2352 x 1568 pixels, FOV: 45 degrees — 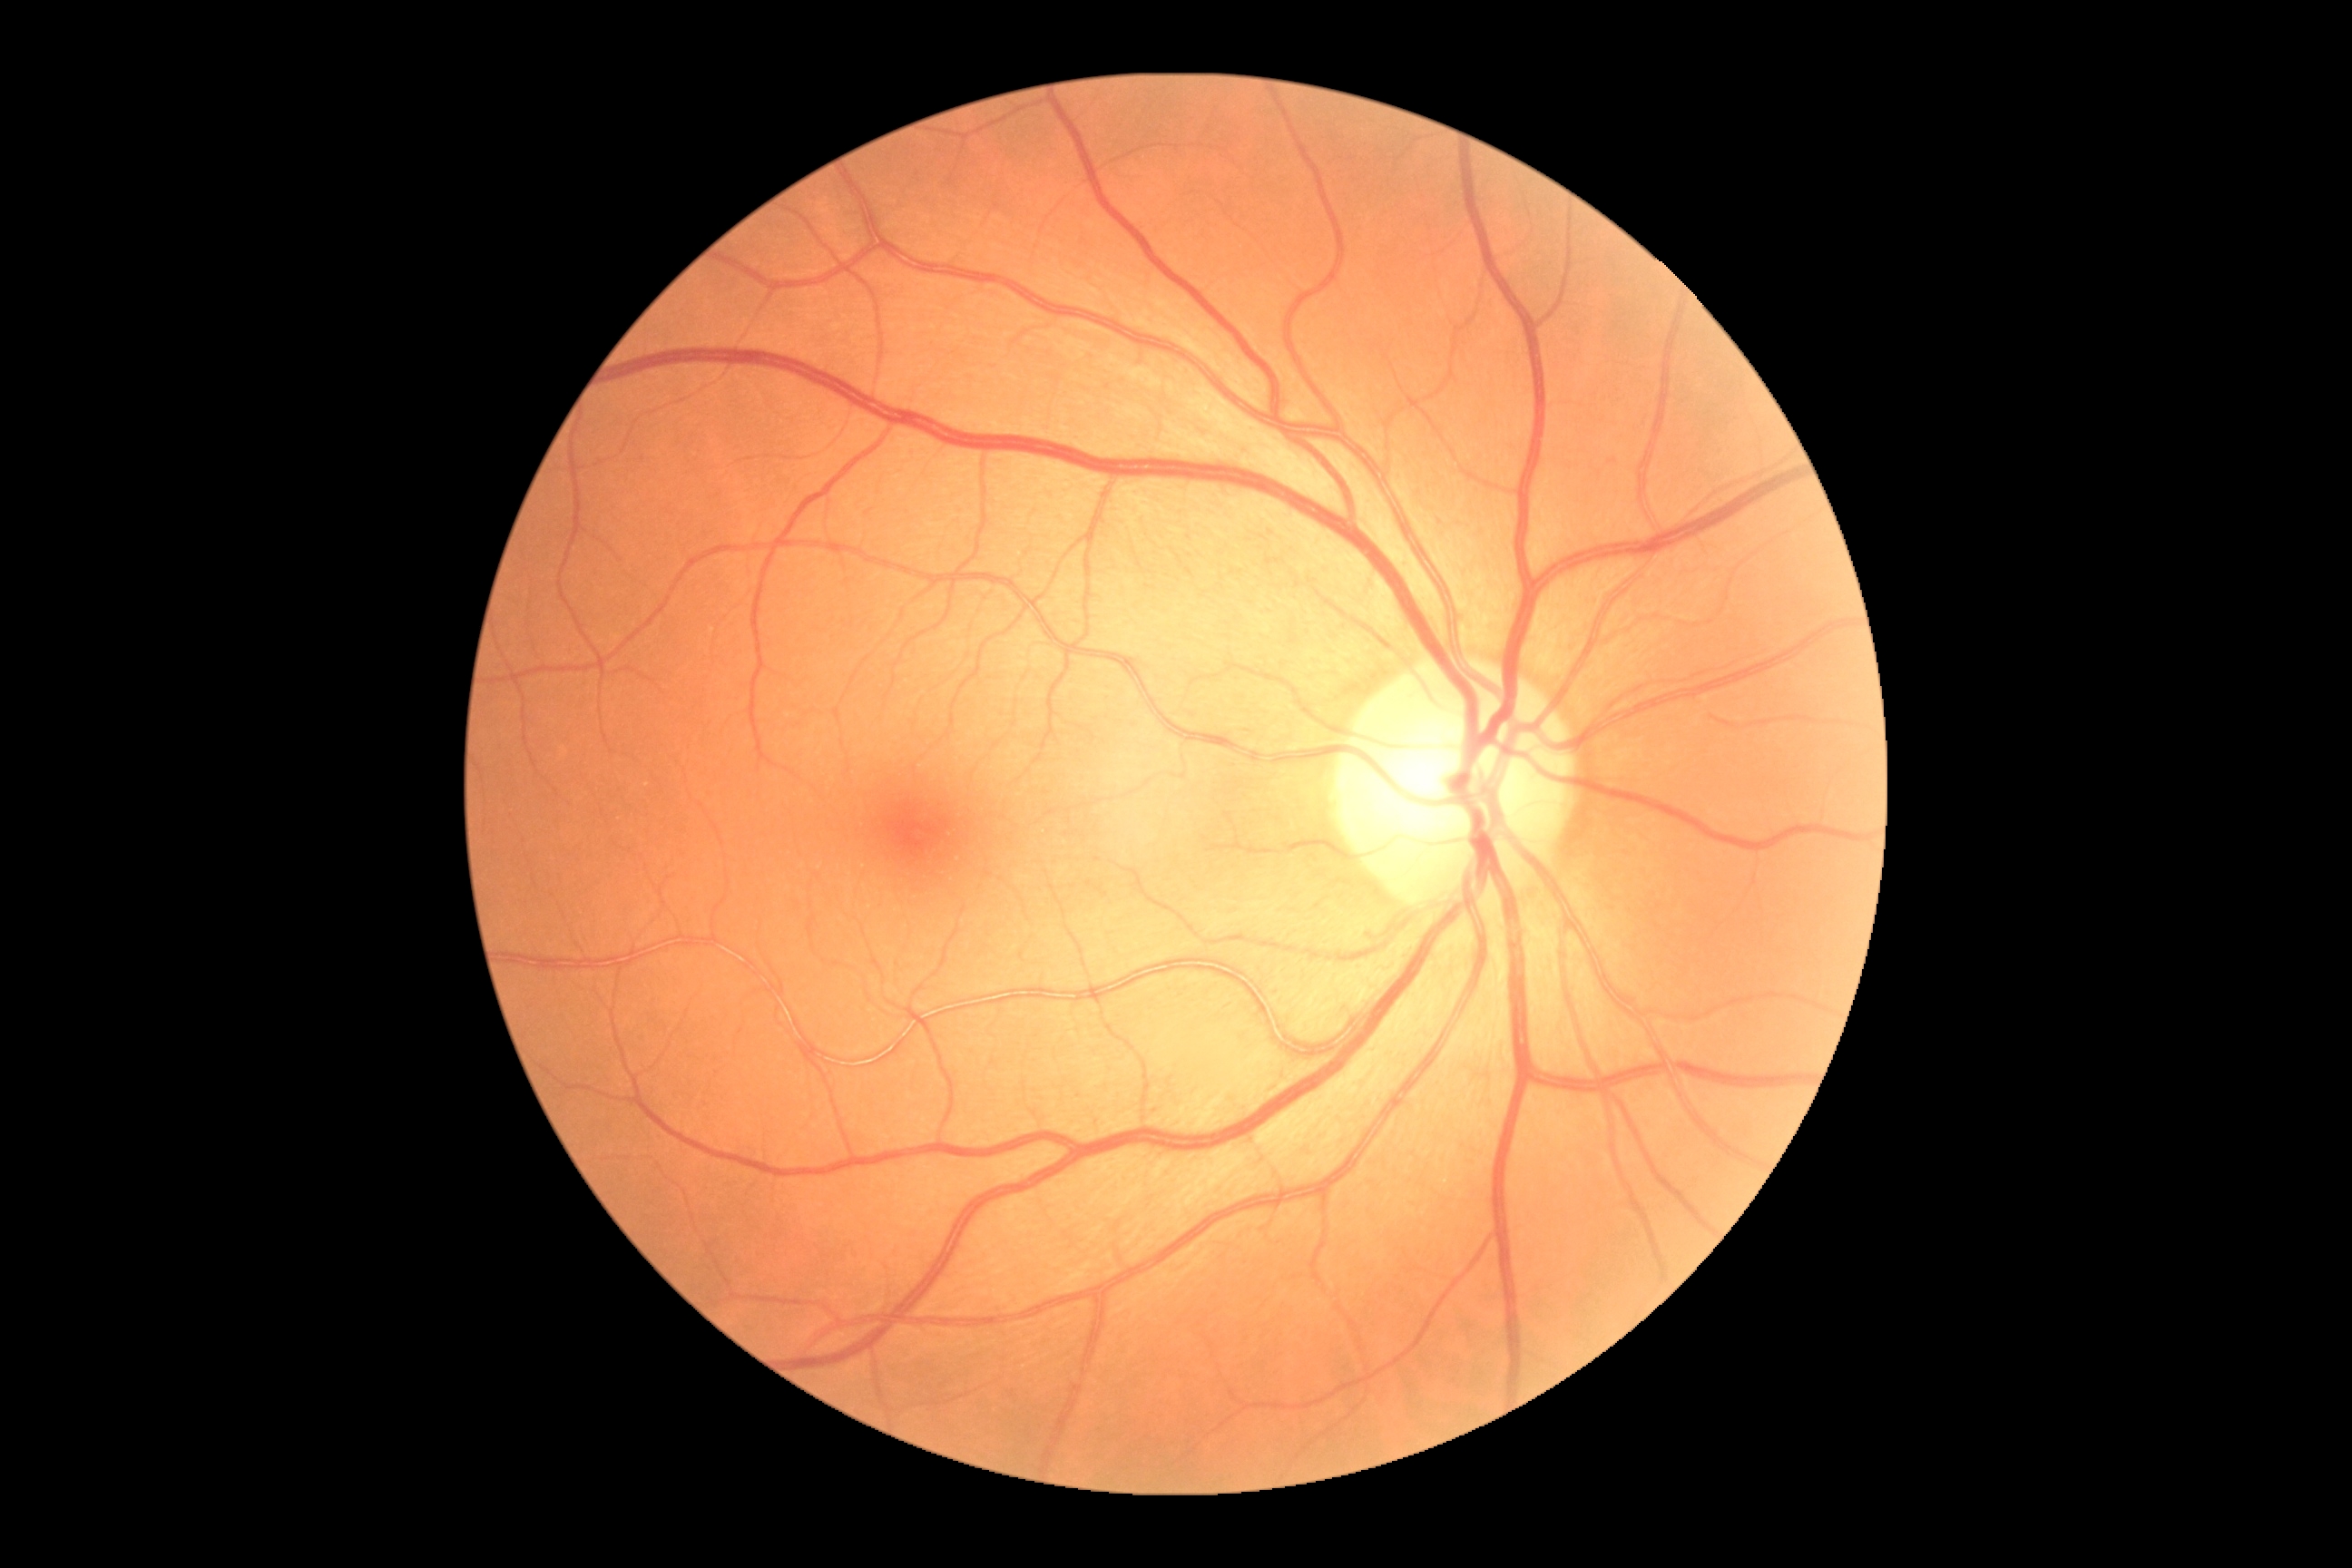 DR grade: 0 (no apparent retinopathy).